1932 by 1916 pixels: 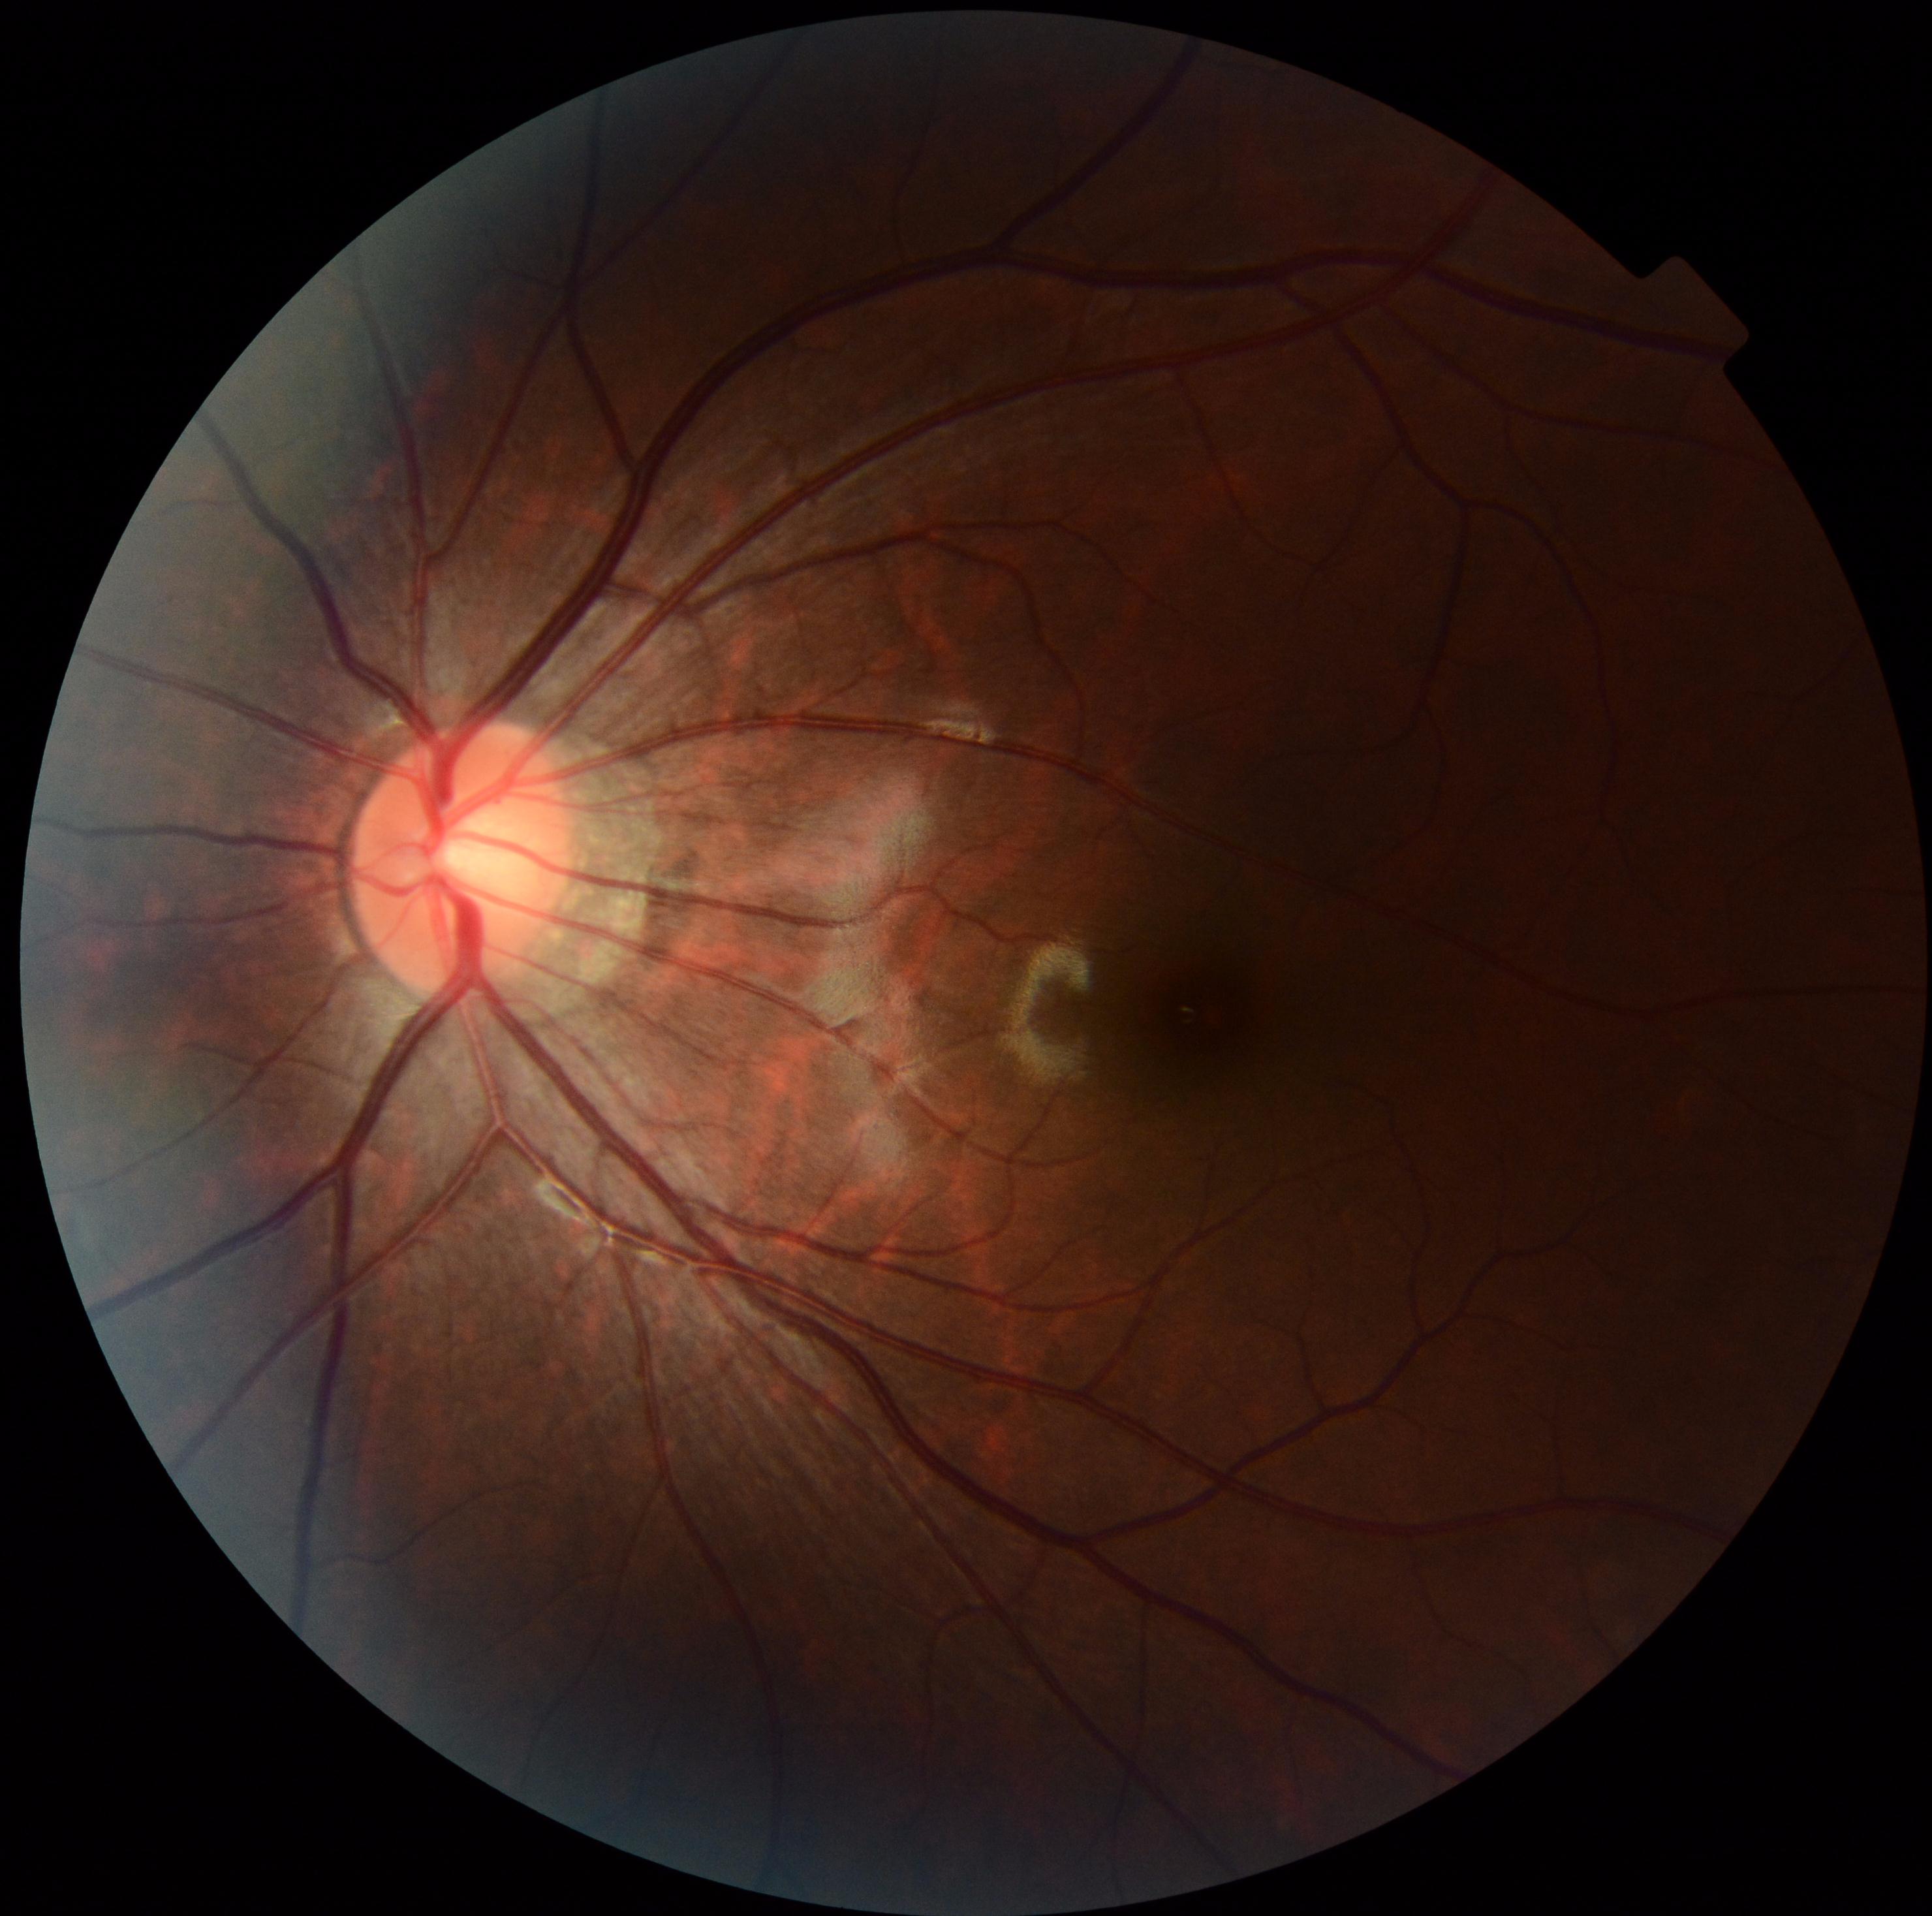 DR severity: 0 — no visible signs of diabetic retinopathy.